Fundus photo · 2102 by 1736 pixels — 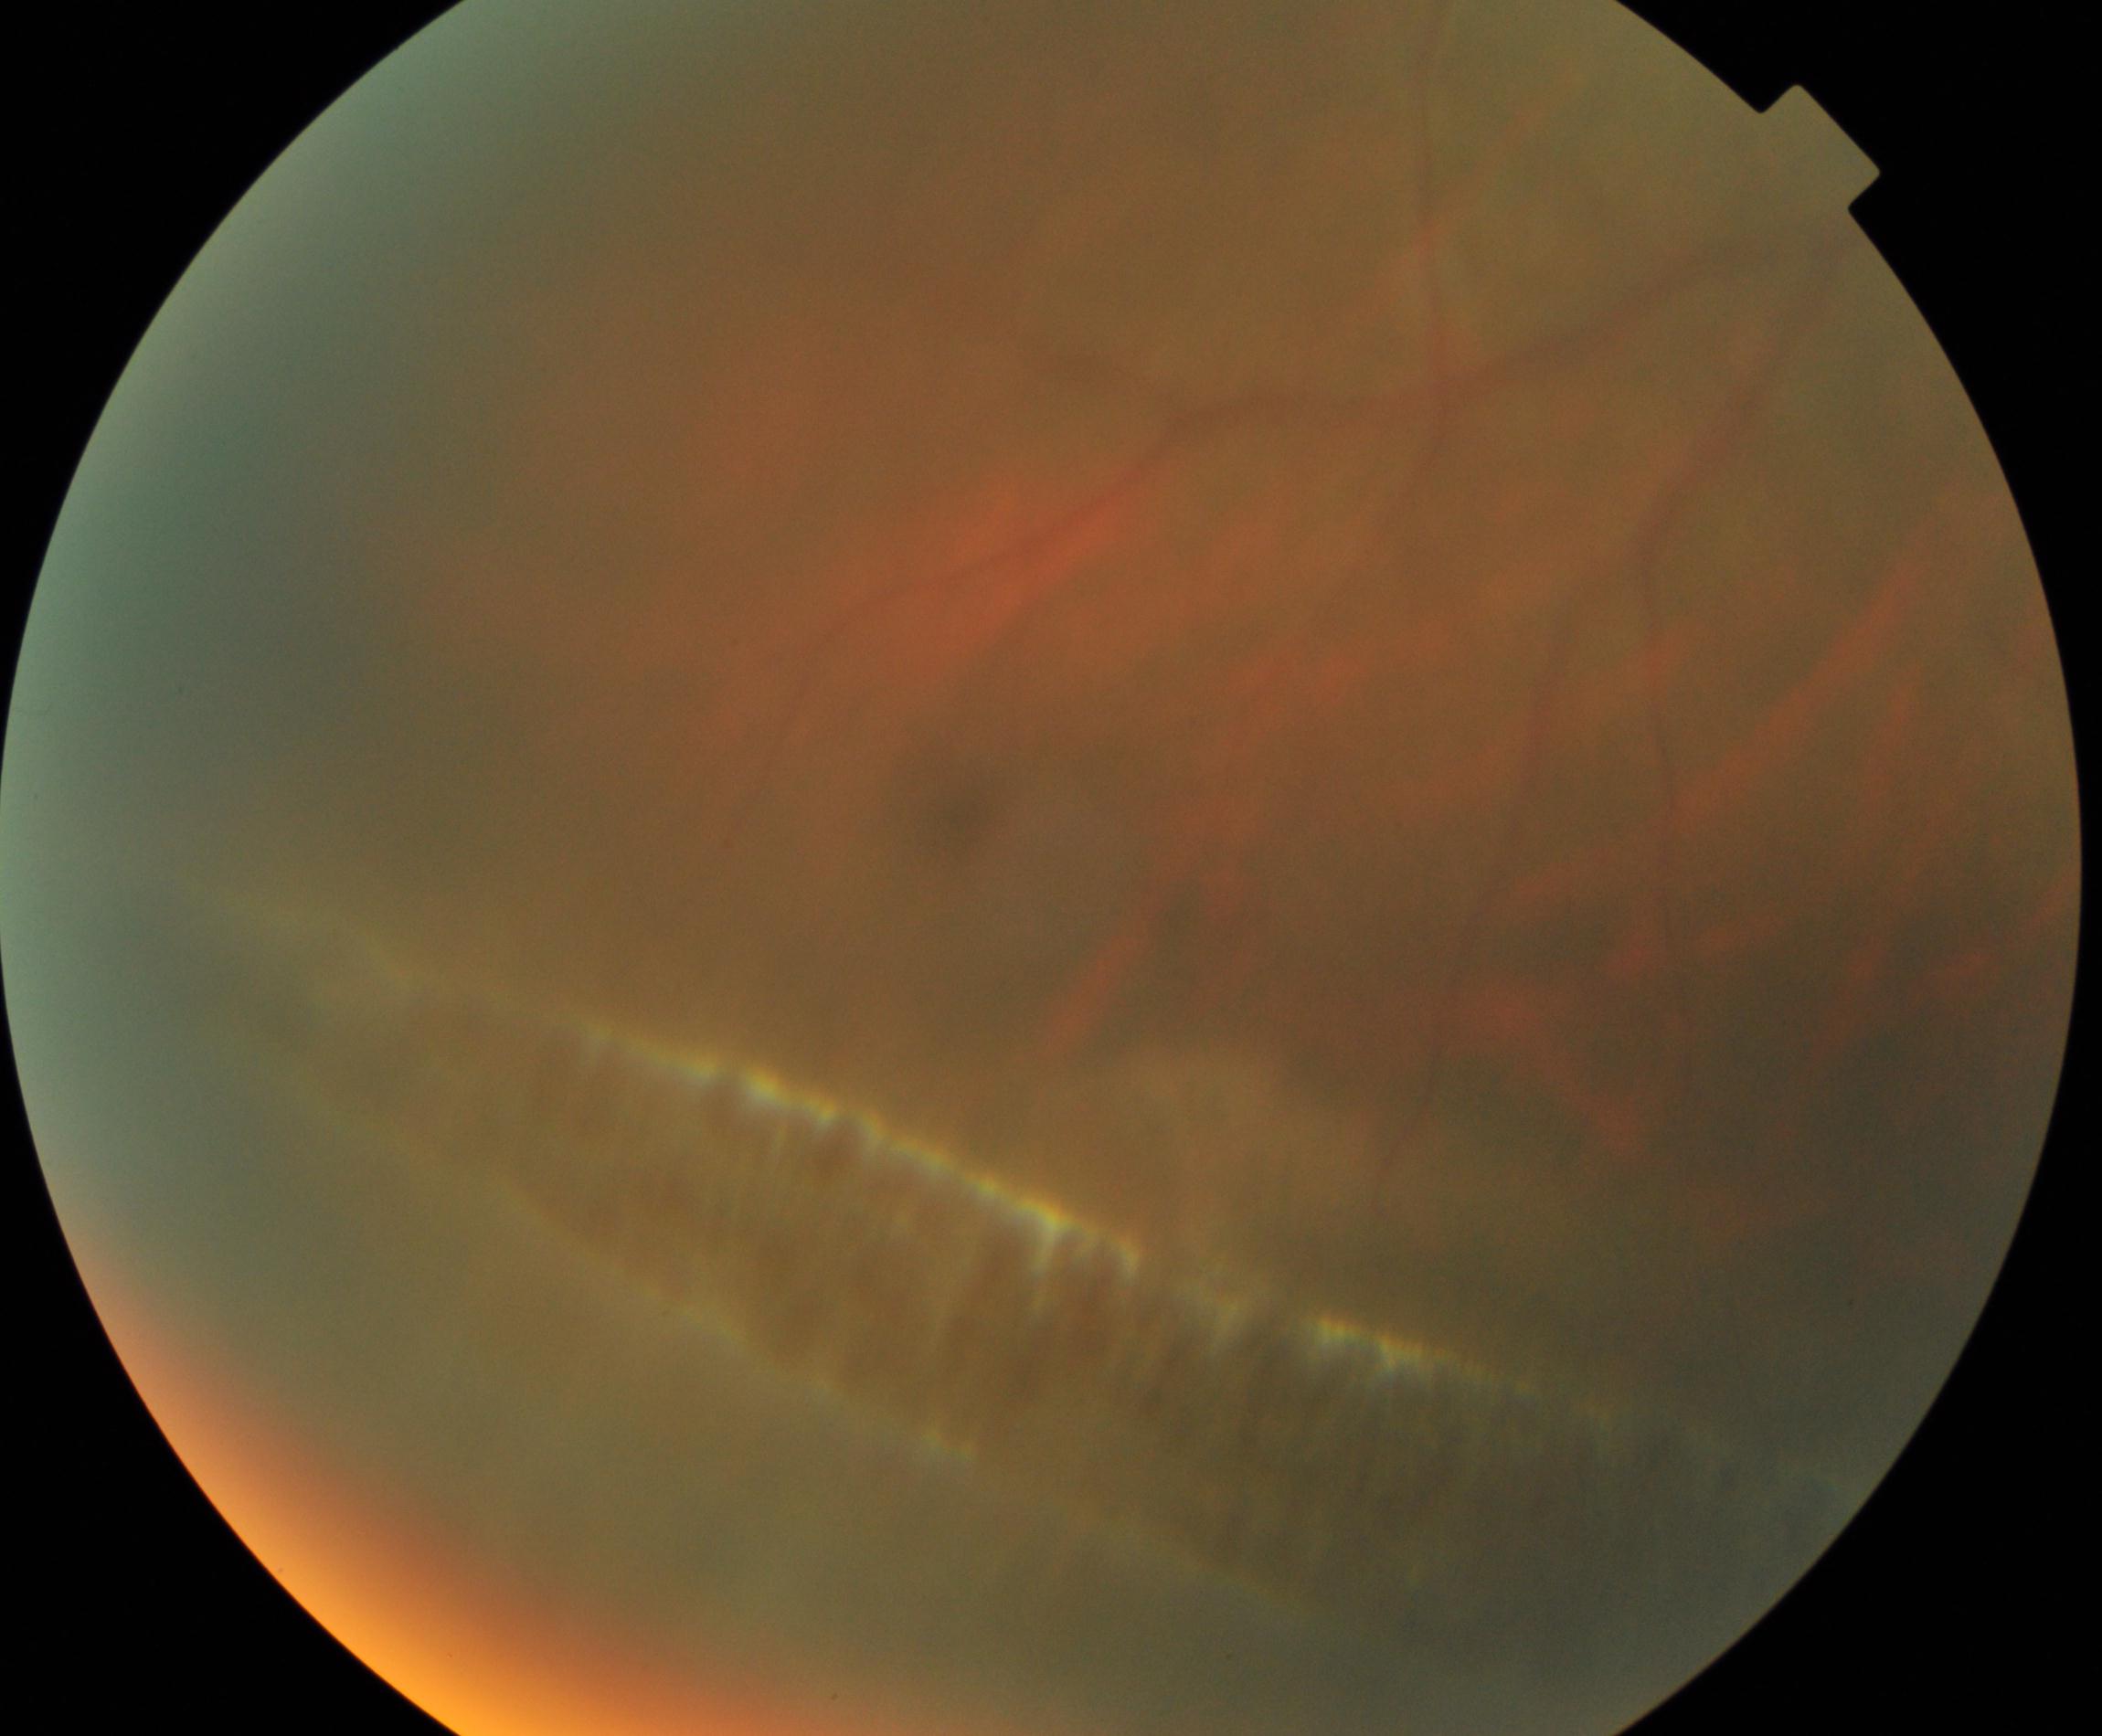 Impression: peripheral retinal degeneration and break.